Nonmydriatic: 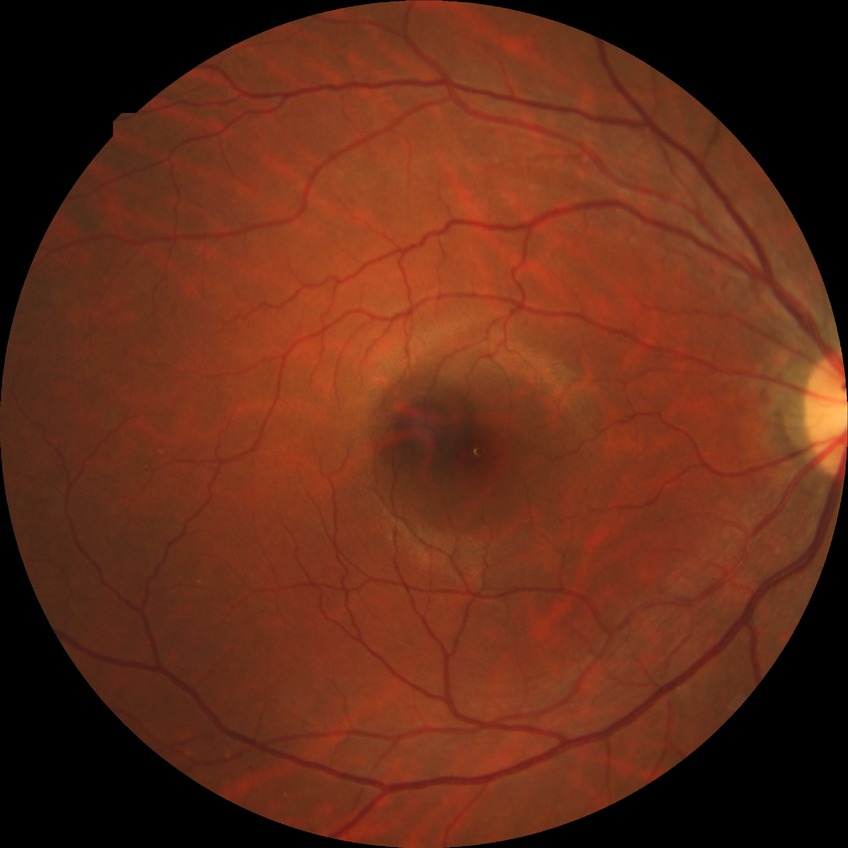

diabetic retinopathy stage: no diabetic retinopathy